Pediatric retinal photograph (wide-field). Camera: Natus RetCam Envision (130° FOV): 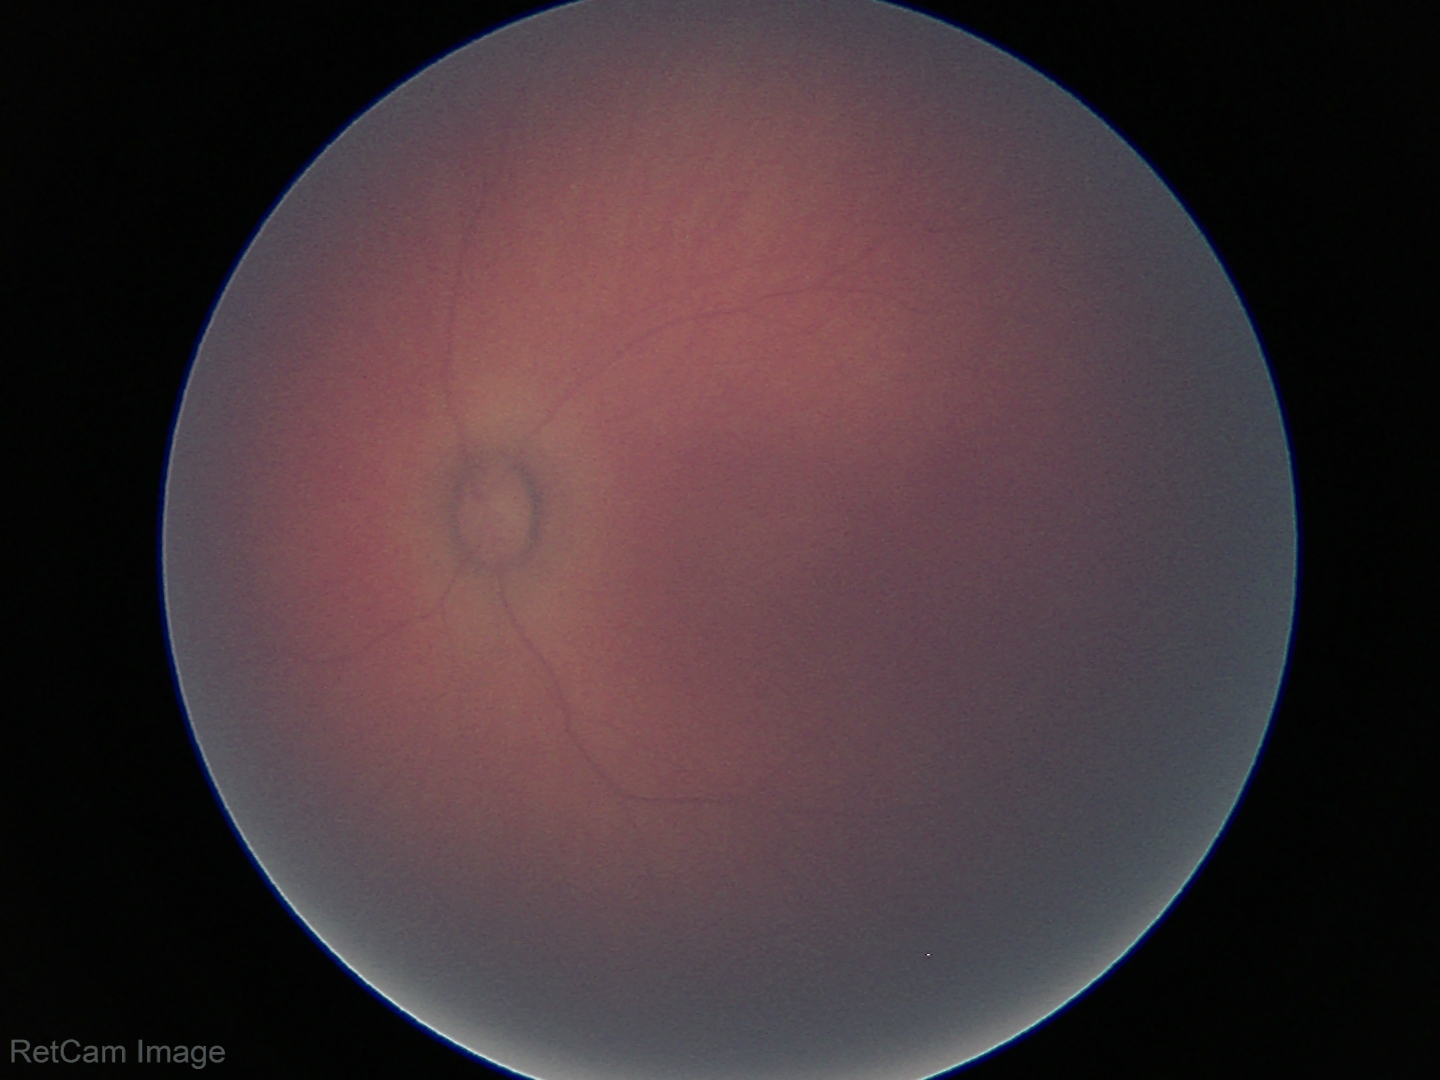

Examination with physiological retinal findings.